FOV: 45 degrees.
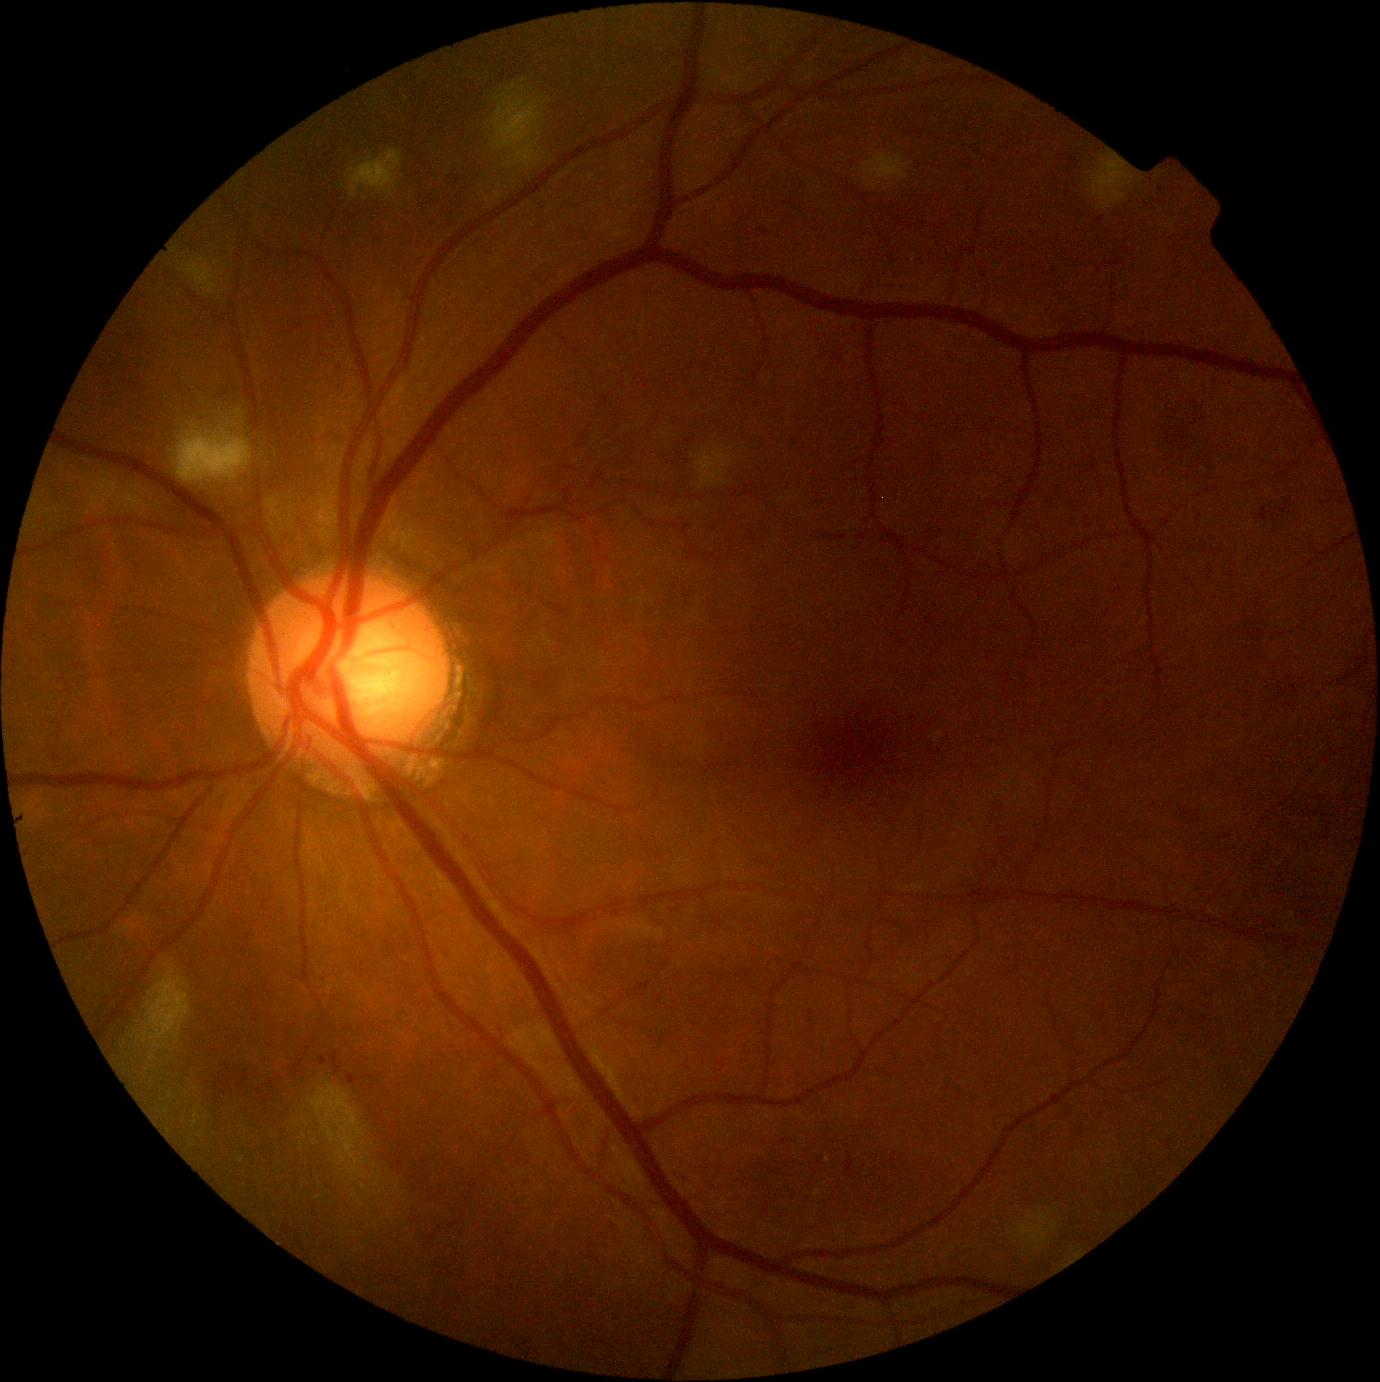 DR class: non-proliferative diabetic retinopathy. Diabetic retinopathy: moderate non-proliferative diabetic retinopathy (grade 2).